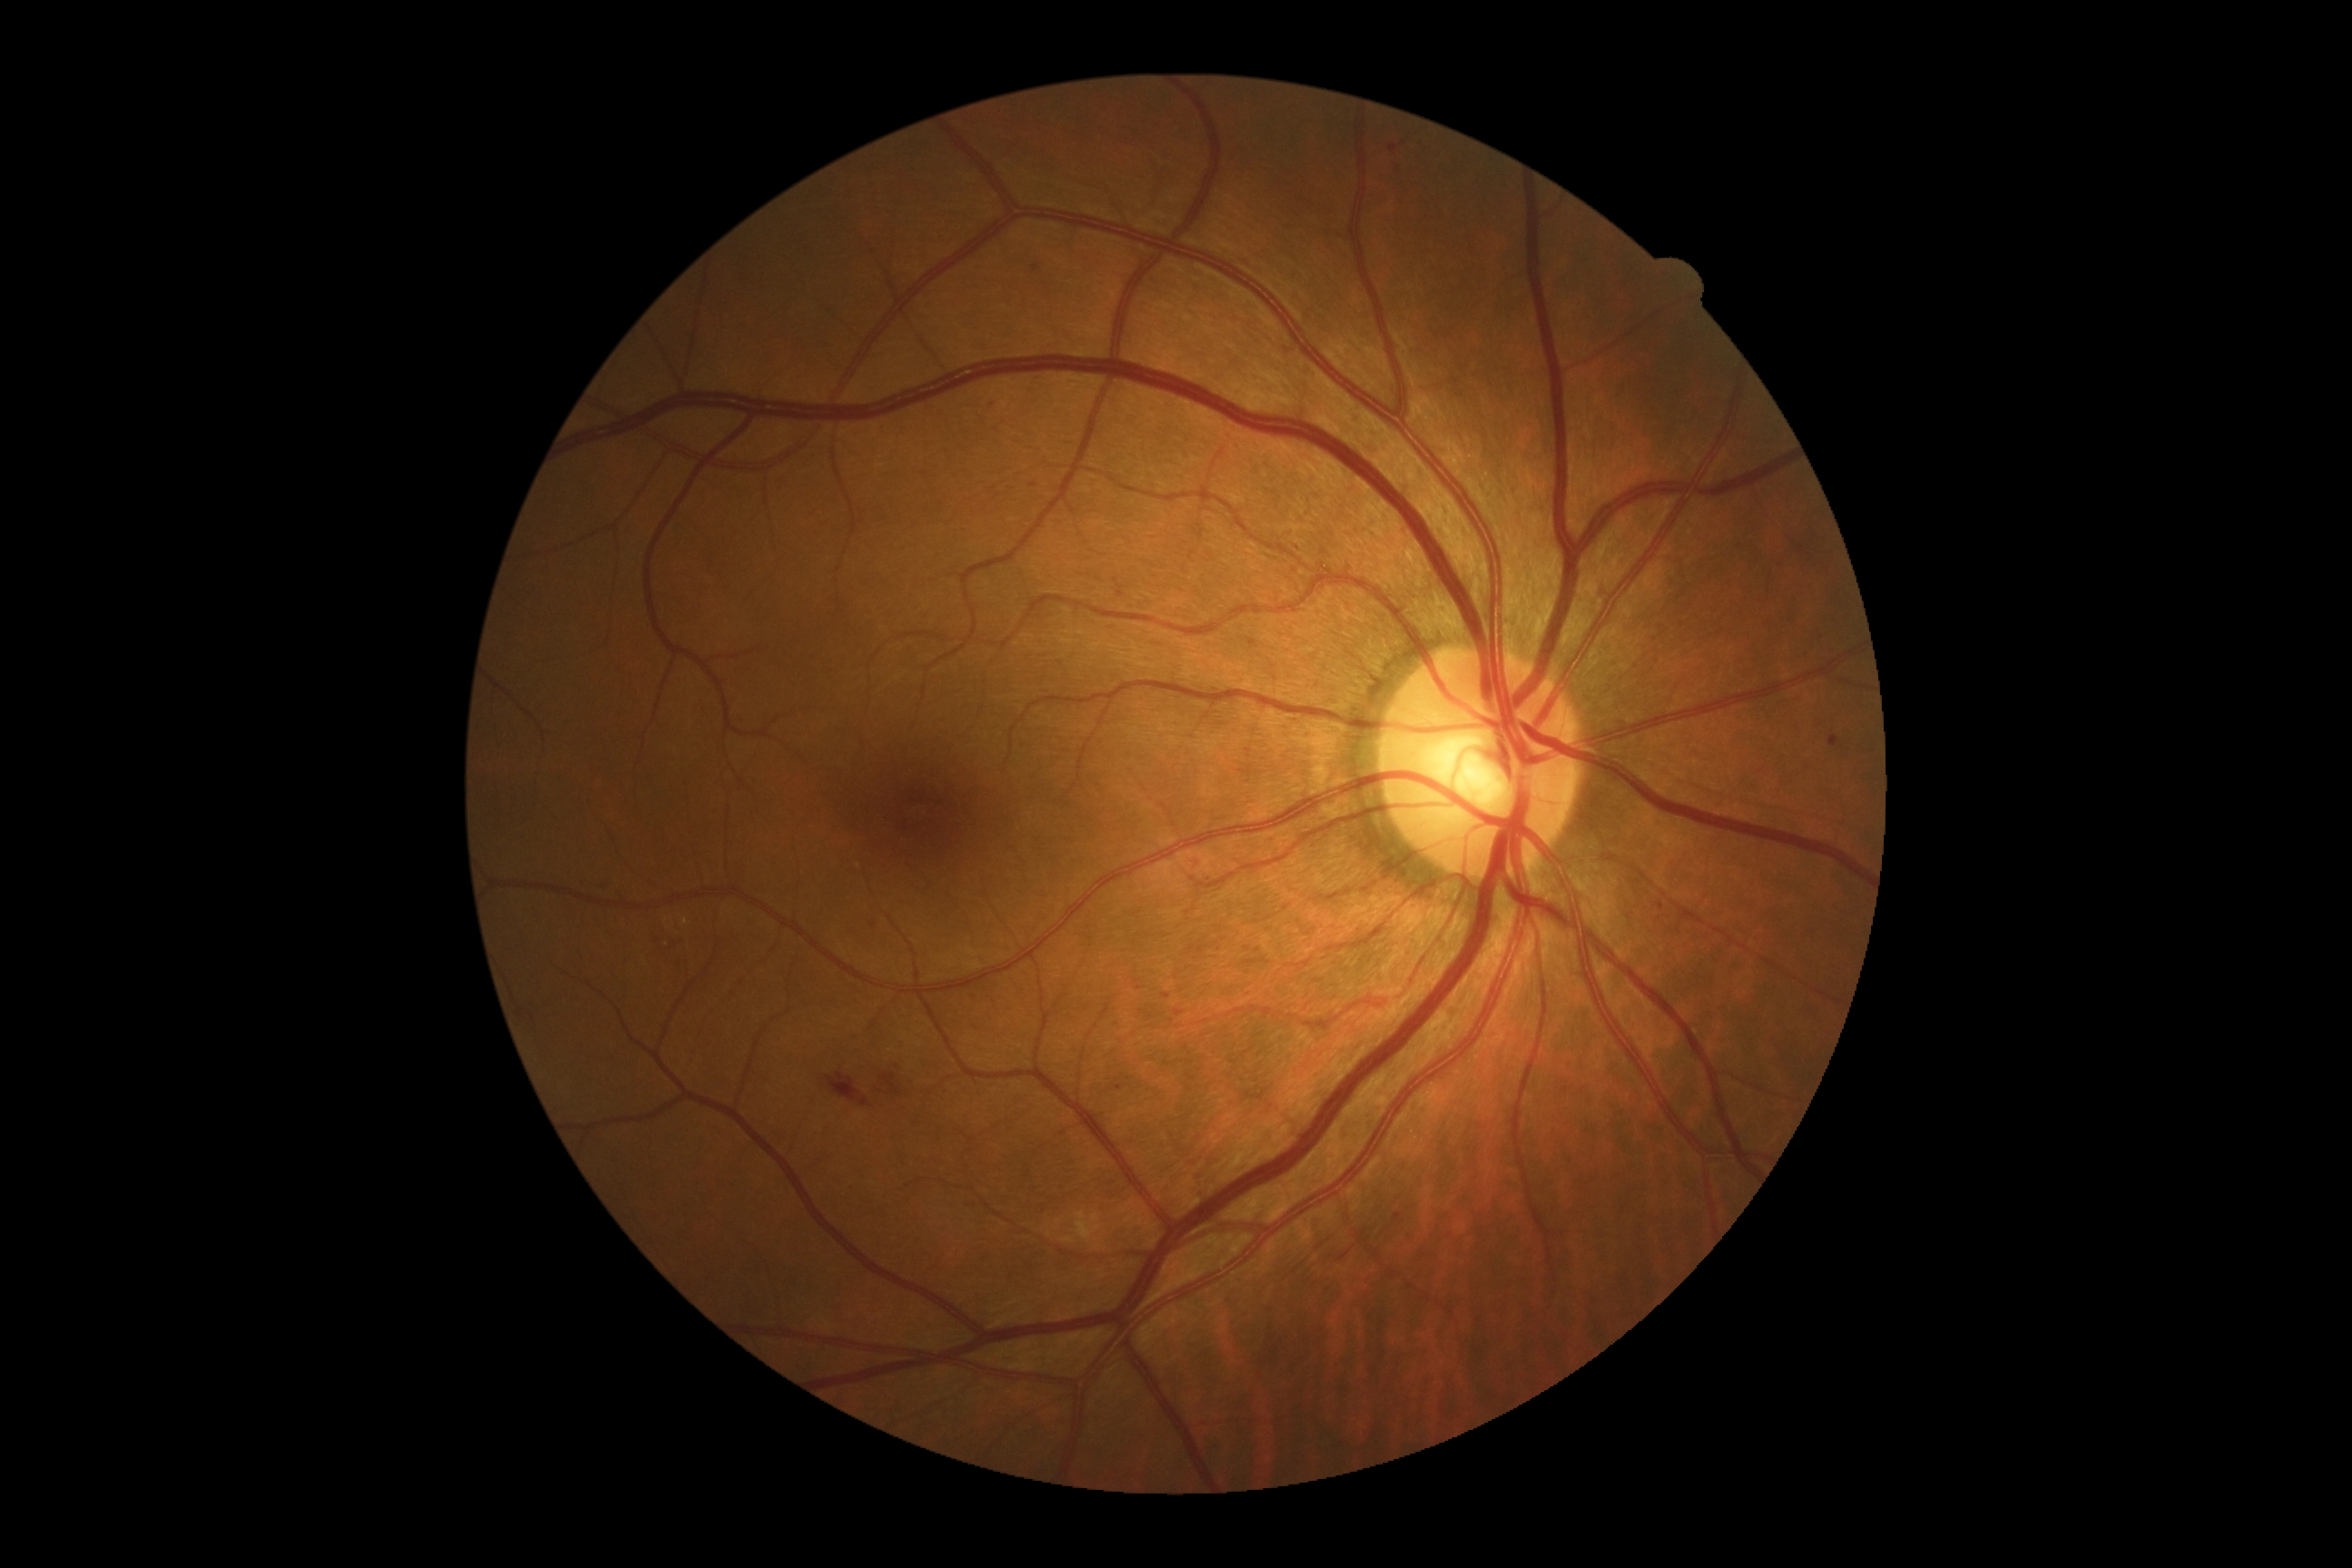
Diabetic retinopathy severity: grade 2 (moderate NPDR) — more than just microaneurysms but less than severe NPDR.